CFP — 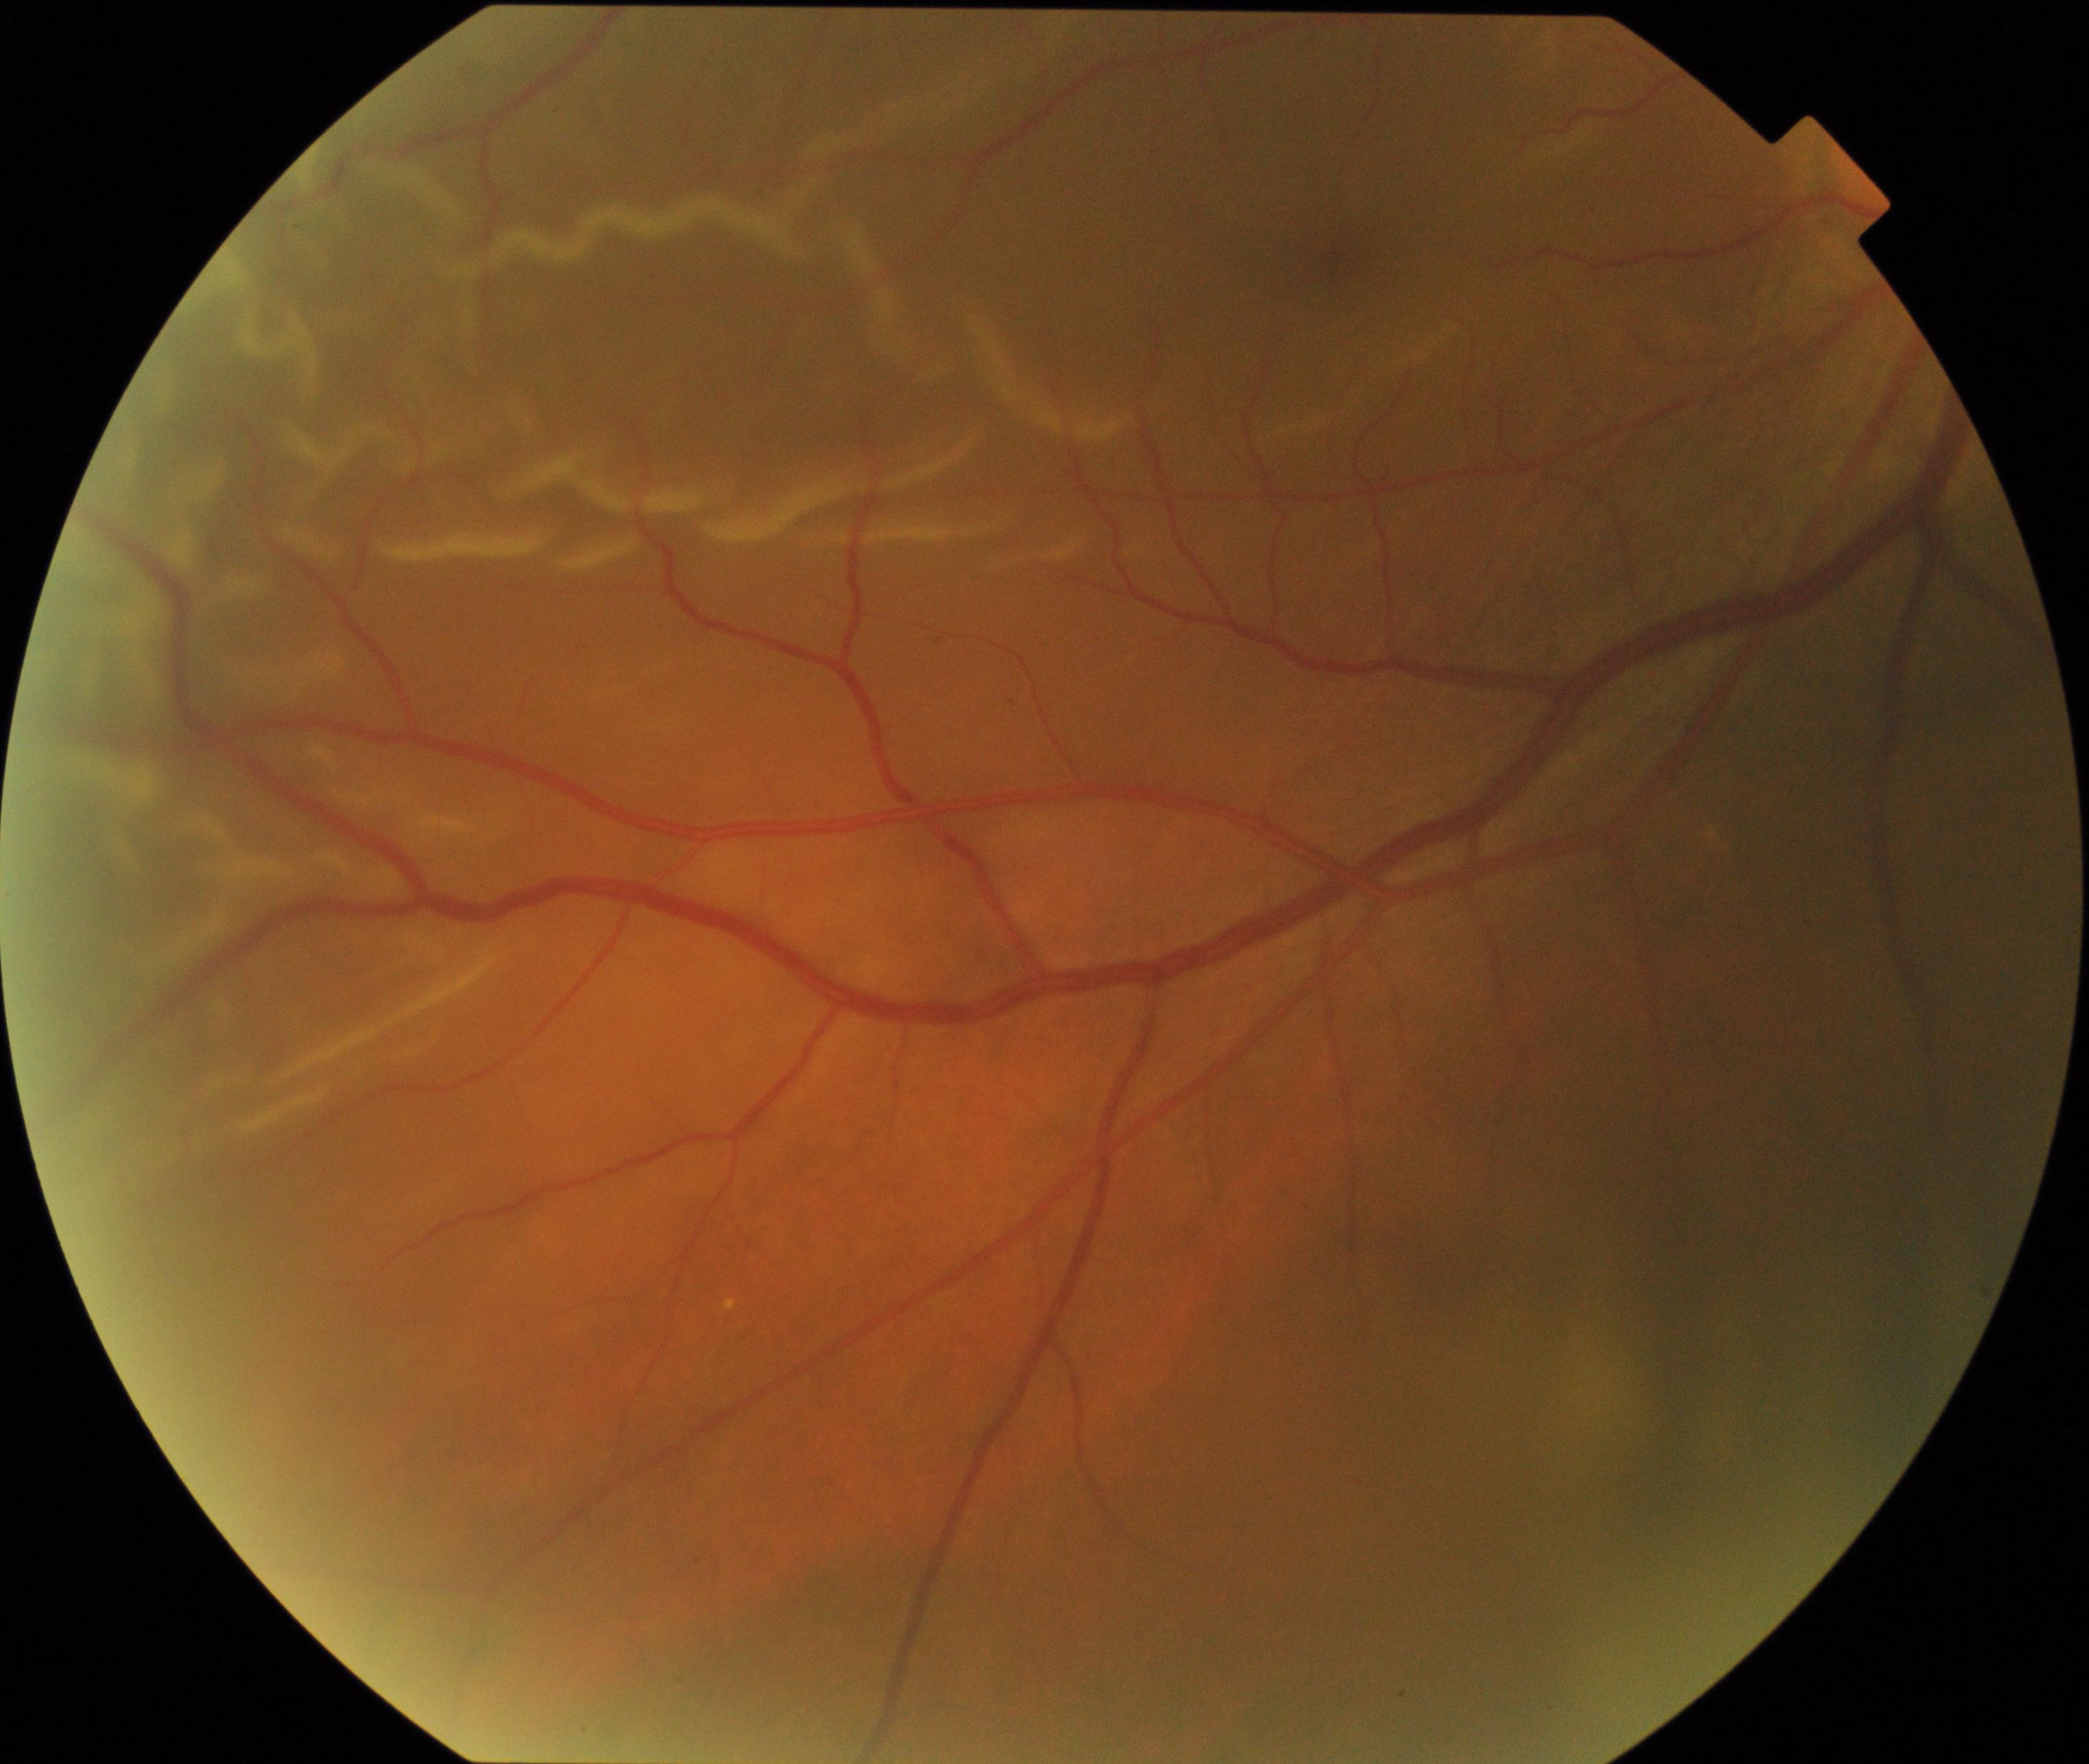 Demonstrates rhegmatogenous retinal detachment.